Fundus photo. 2212 x 1659 pixels. 45° field of view
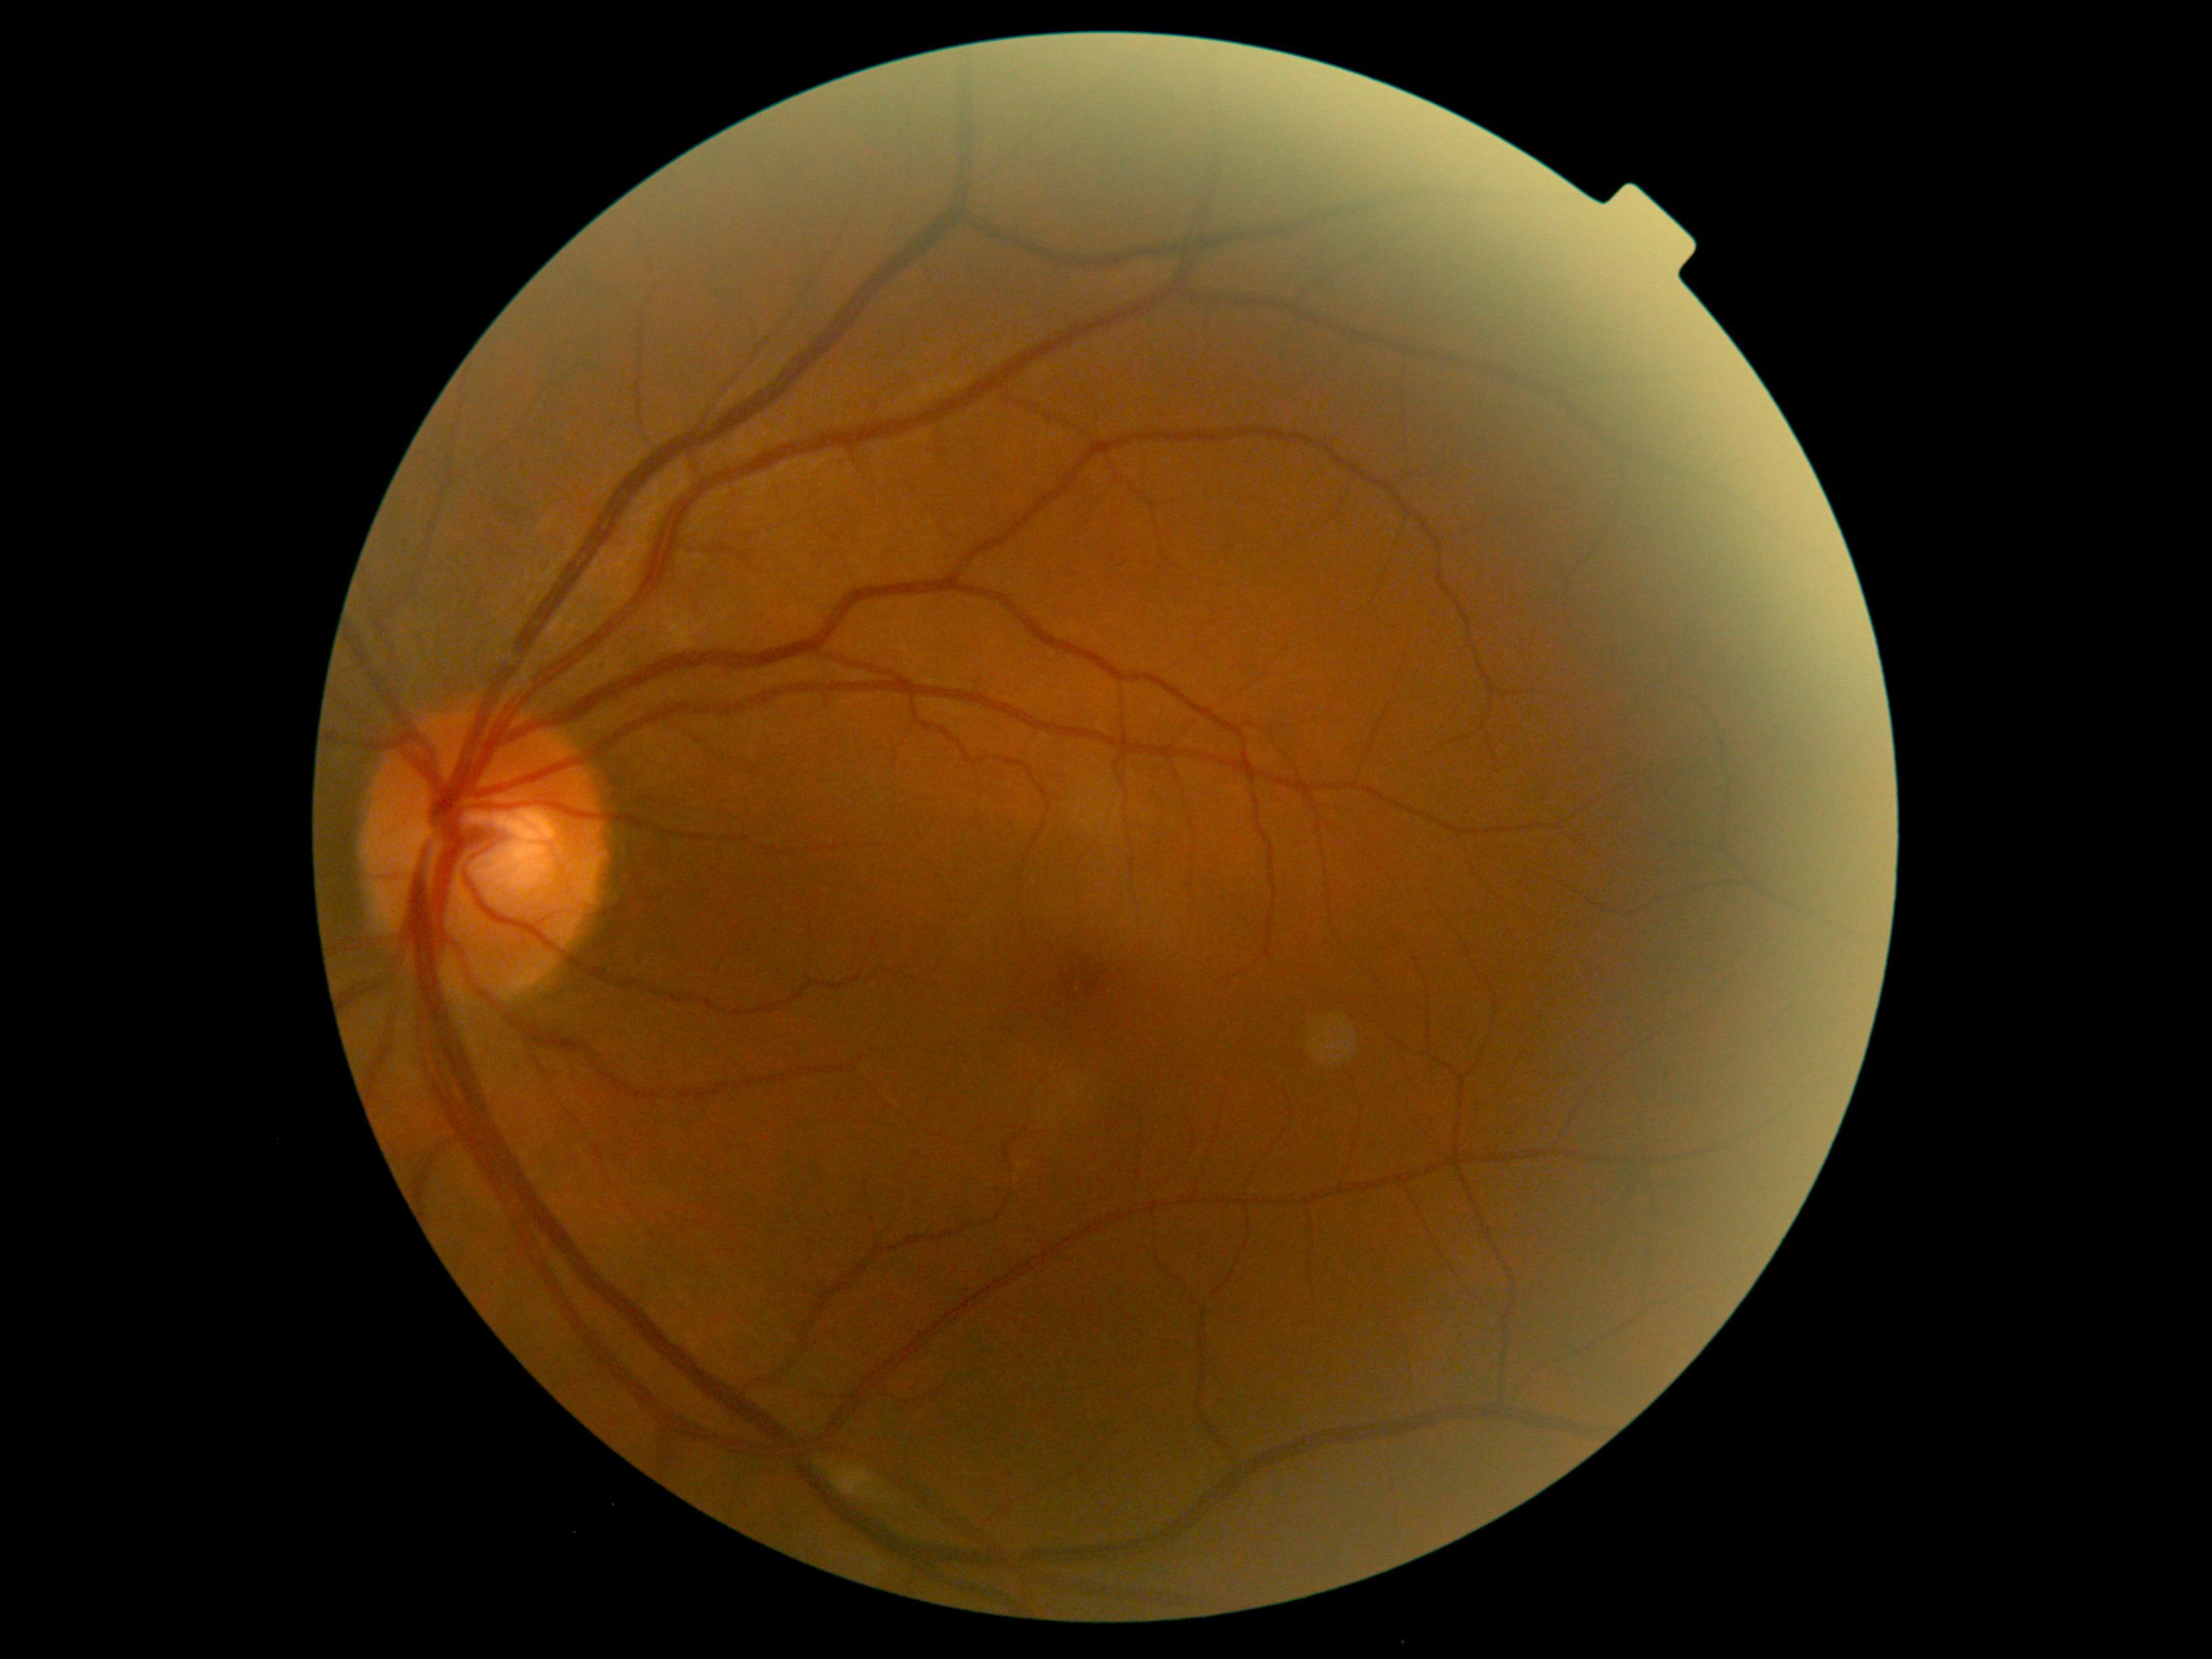
dr_grade: moderate NPDR (grade 2) — more than just microaneurysms but less than severe NPDR
dr_category: non-proliferative diabetic retinopathy